45° FOV
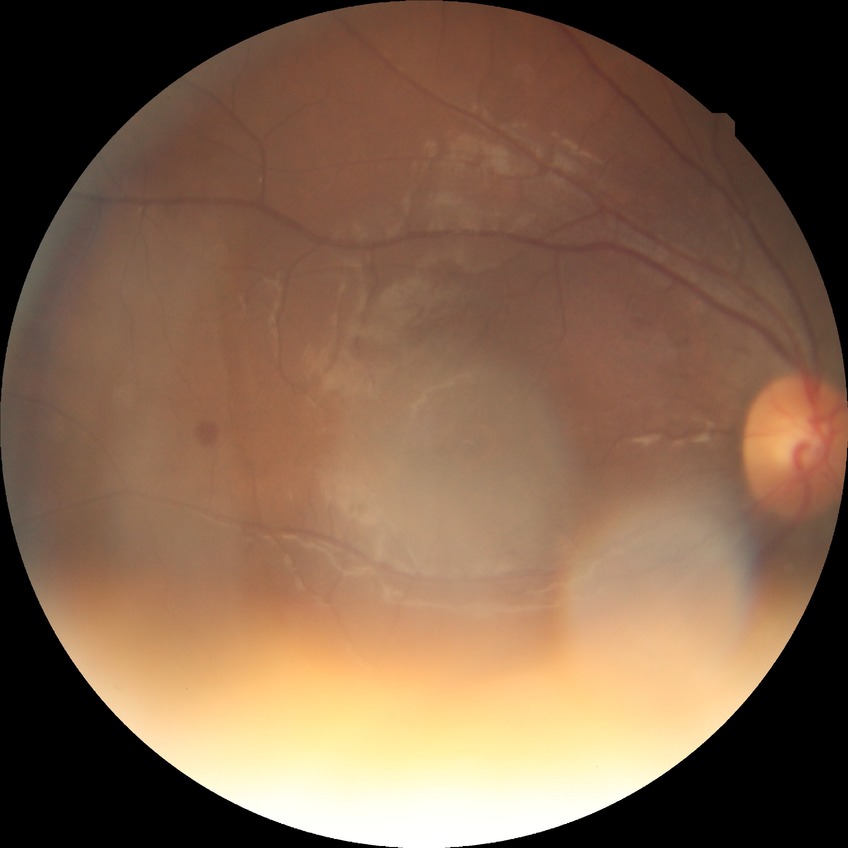 Diabetic retinopathy (DR) is NDR (no diabetic retinopathy).